1240 x 1240 pixels · infant wide-field fundus photograph · Phoenix ICON, 100° FOV
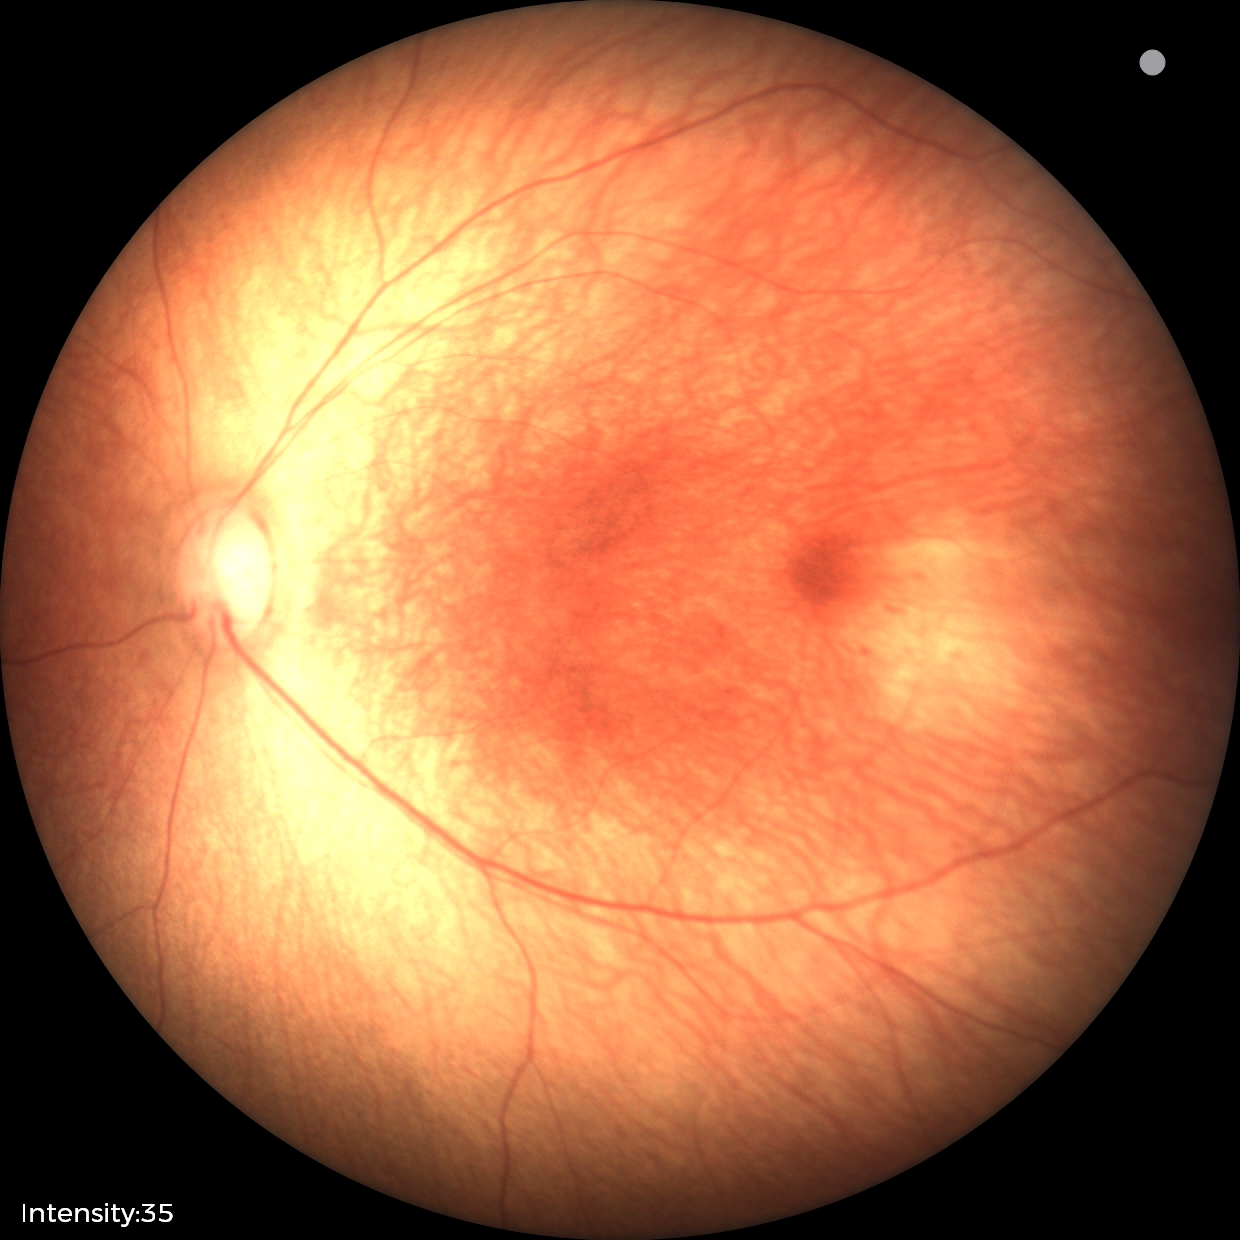 Diagnosis: no pathology identified.